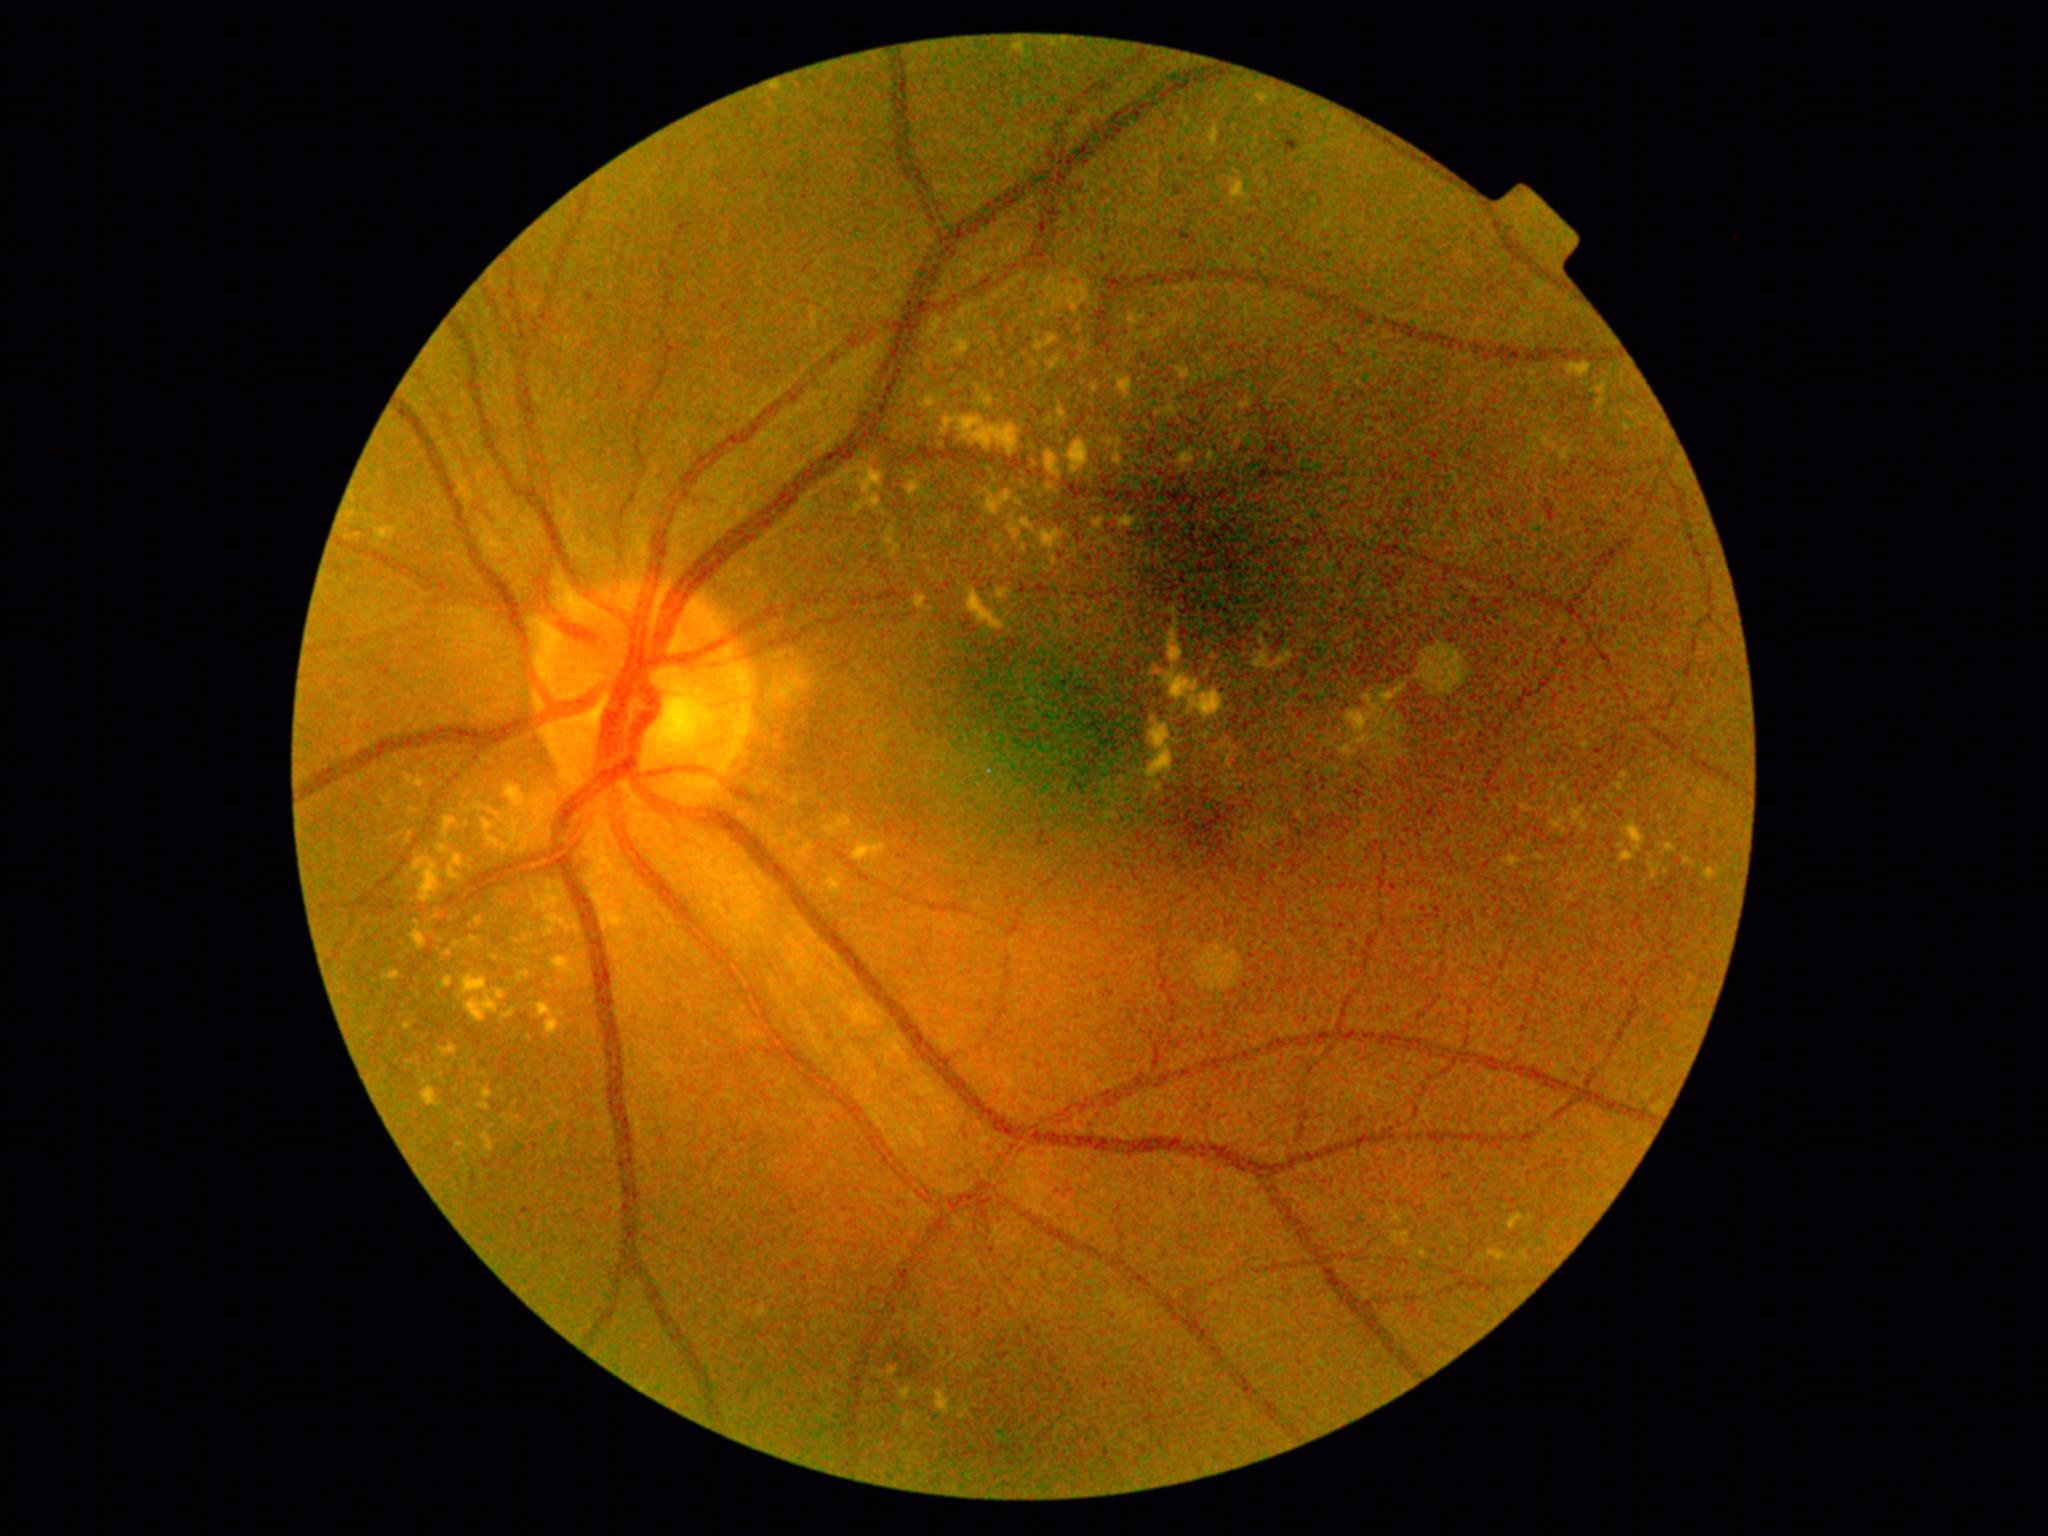

DR grade is 2. HEs are located at bbox=[884, 1349, 926, 1379]. No SEs identified. EXs include bbox=[1118, 378, 1131, 394], bbox=[989, 494, 1010, 514], bbox=[483, 1090, 493, 1100], bbox=[884, 530, 897, 552], bbox=[1103, 440, 1112, 446], bbox=[828, 881, 841, 892], bbox=[940, 417, 1019, 458], bbox=[1176, 368, 1186, 380], bbox=[489, 1143, 493, 1152], bbox=[1069, 307, 1080, 315], bbox=[1046, 450, 1065, 490], bbox=[1090, 385, 1098, 393], bbox=[416, 779, 424, 788]. Additional small EXs near [1160, 788], [1423, 1253], [538, 803], [449, 954], [1399, 1219]. MAs are located at bbox=[1550, 511, 1555, 521], bbox=[1179, 155, 1188, 165], bbox=[1287, 142, 1297, 152]. Additional small MAs near [1185, 238], [1620, 512], [1493, 516], [592, 298].